Image size 412x310
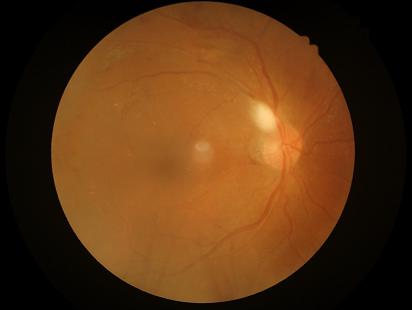

Image quality:
- contrast: wide intensity range, structures distinguishable
- overall: poor, ungradable
- sharpness: reduced sharpness with visible blur
- illumination/color: uneven illumination or color cast